Modified Davis grading
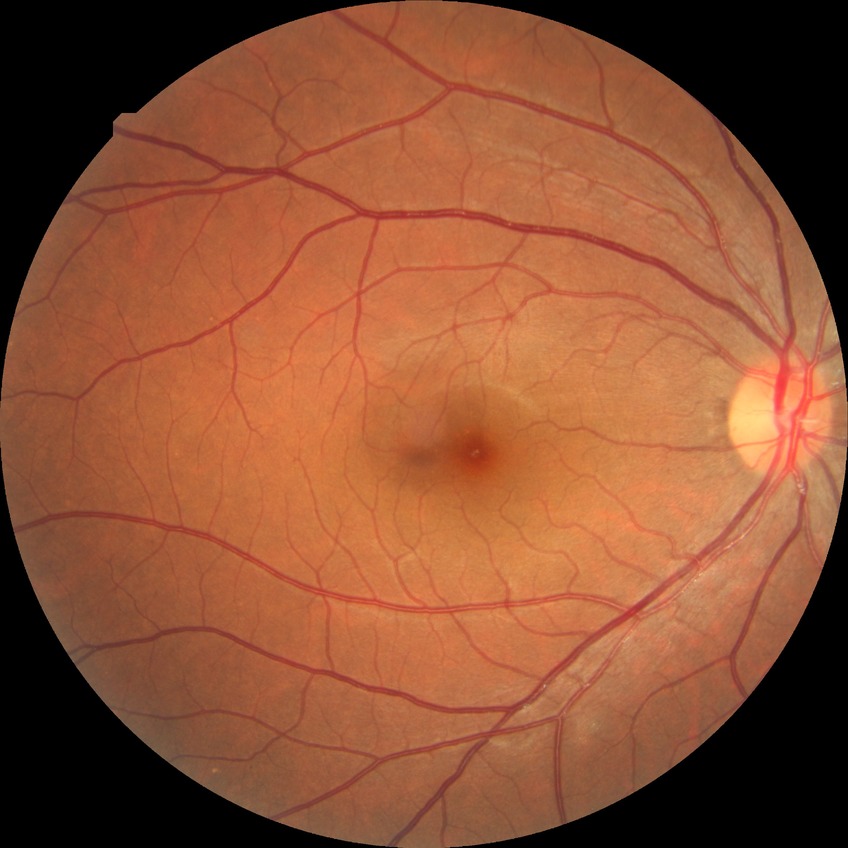
diabetic retinopathy (DR)=no diabetic retinopathy (NDR).